Modified Davis grading:
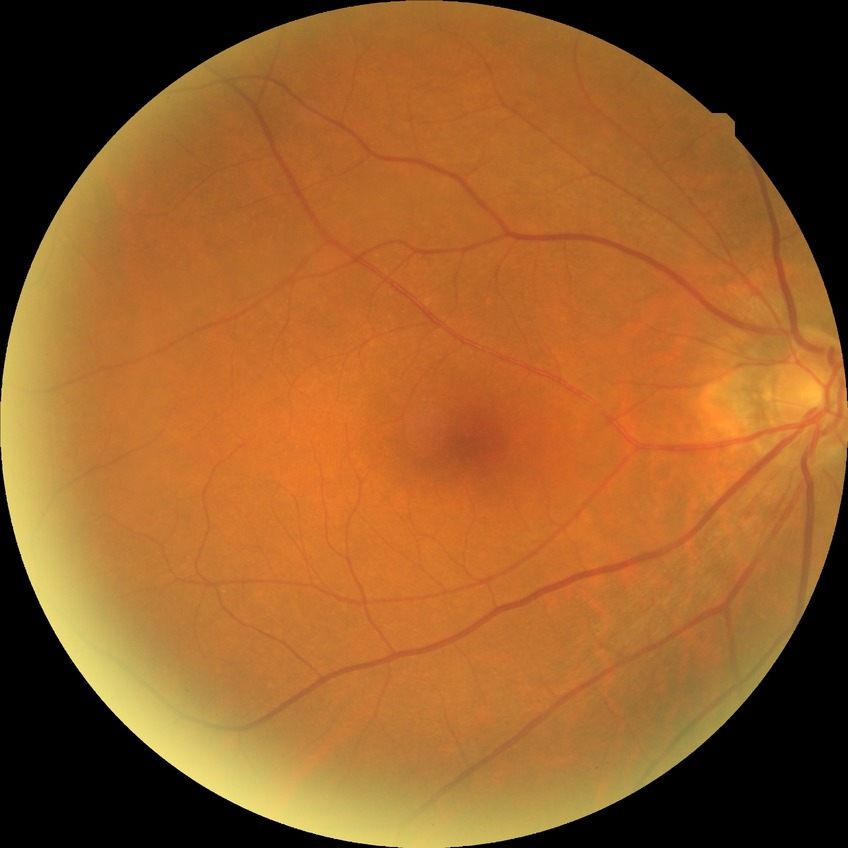

Diabetic retinopathy (DR) is NDR (no diabetic retinopathy).